Acquired with a Nidek AFC-330, optic nerve head crop:
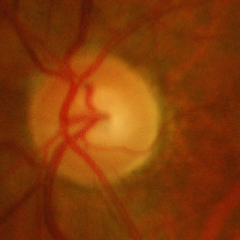

Assessment: advanced-stage glaucoma.